Nonmydriatic · 848 by 848 pixels · NIDEK AFC-230 · Davis DR grading:
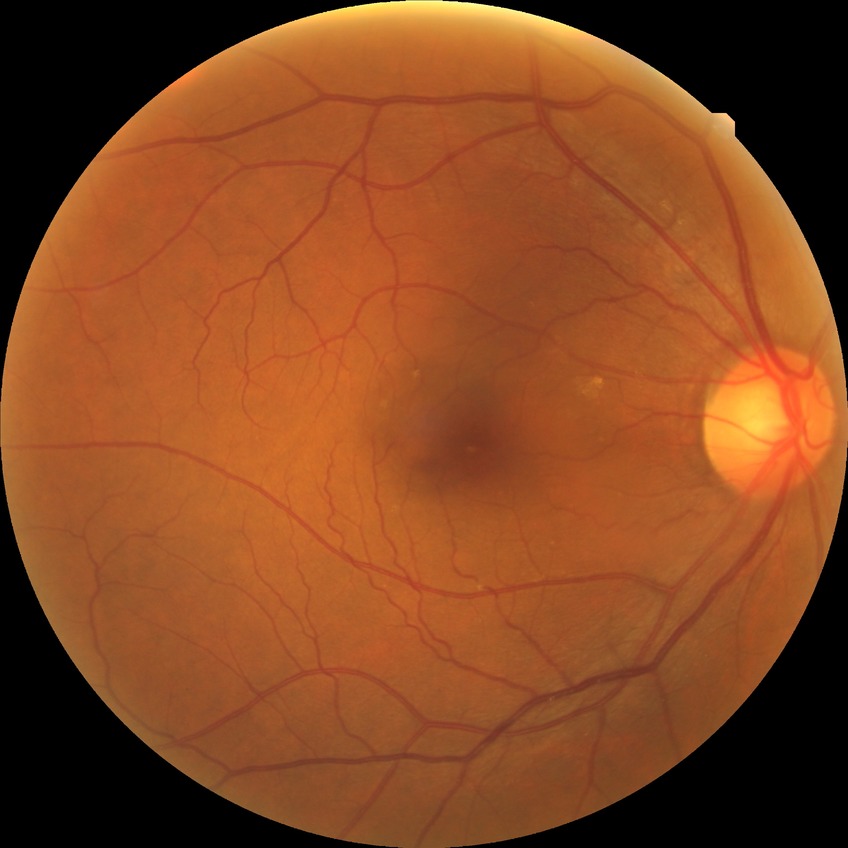 Diabetic retinopathy grade is no diabetic retinopathy.